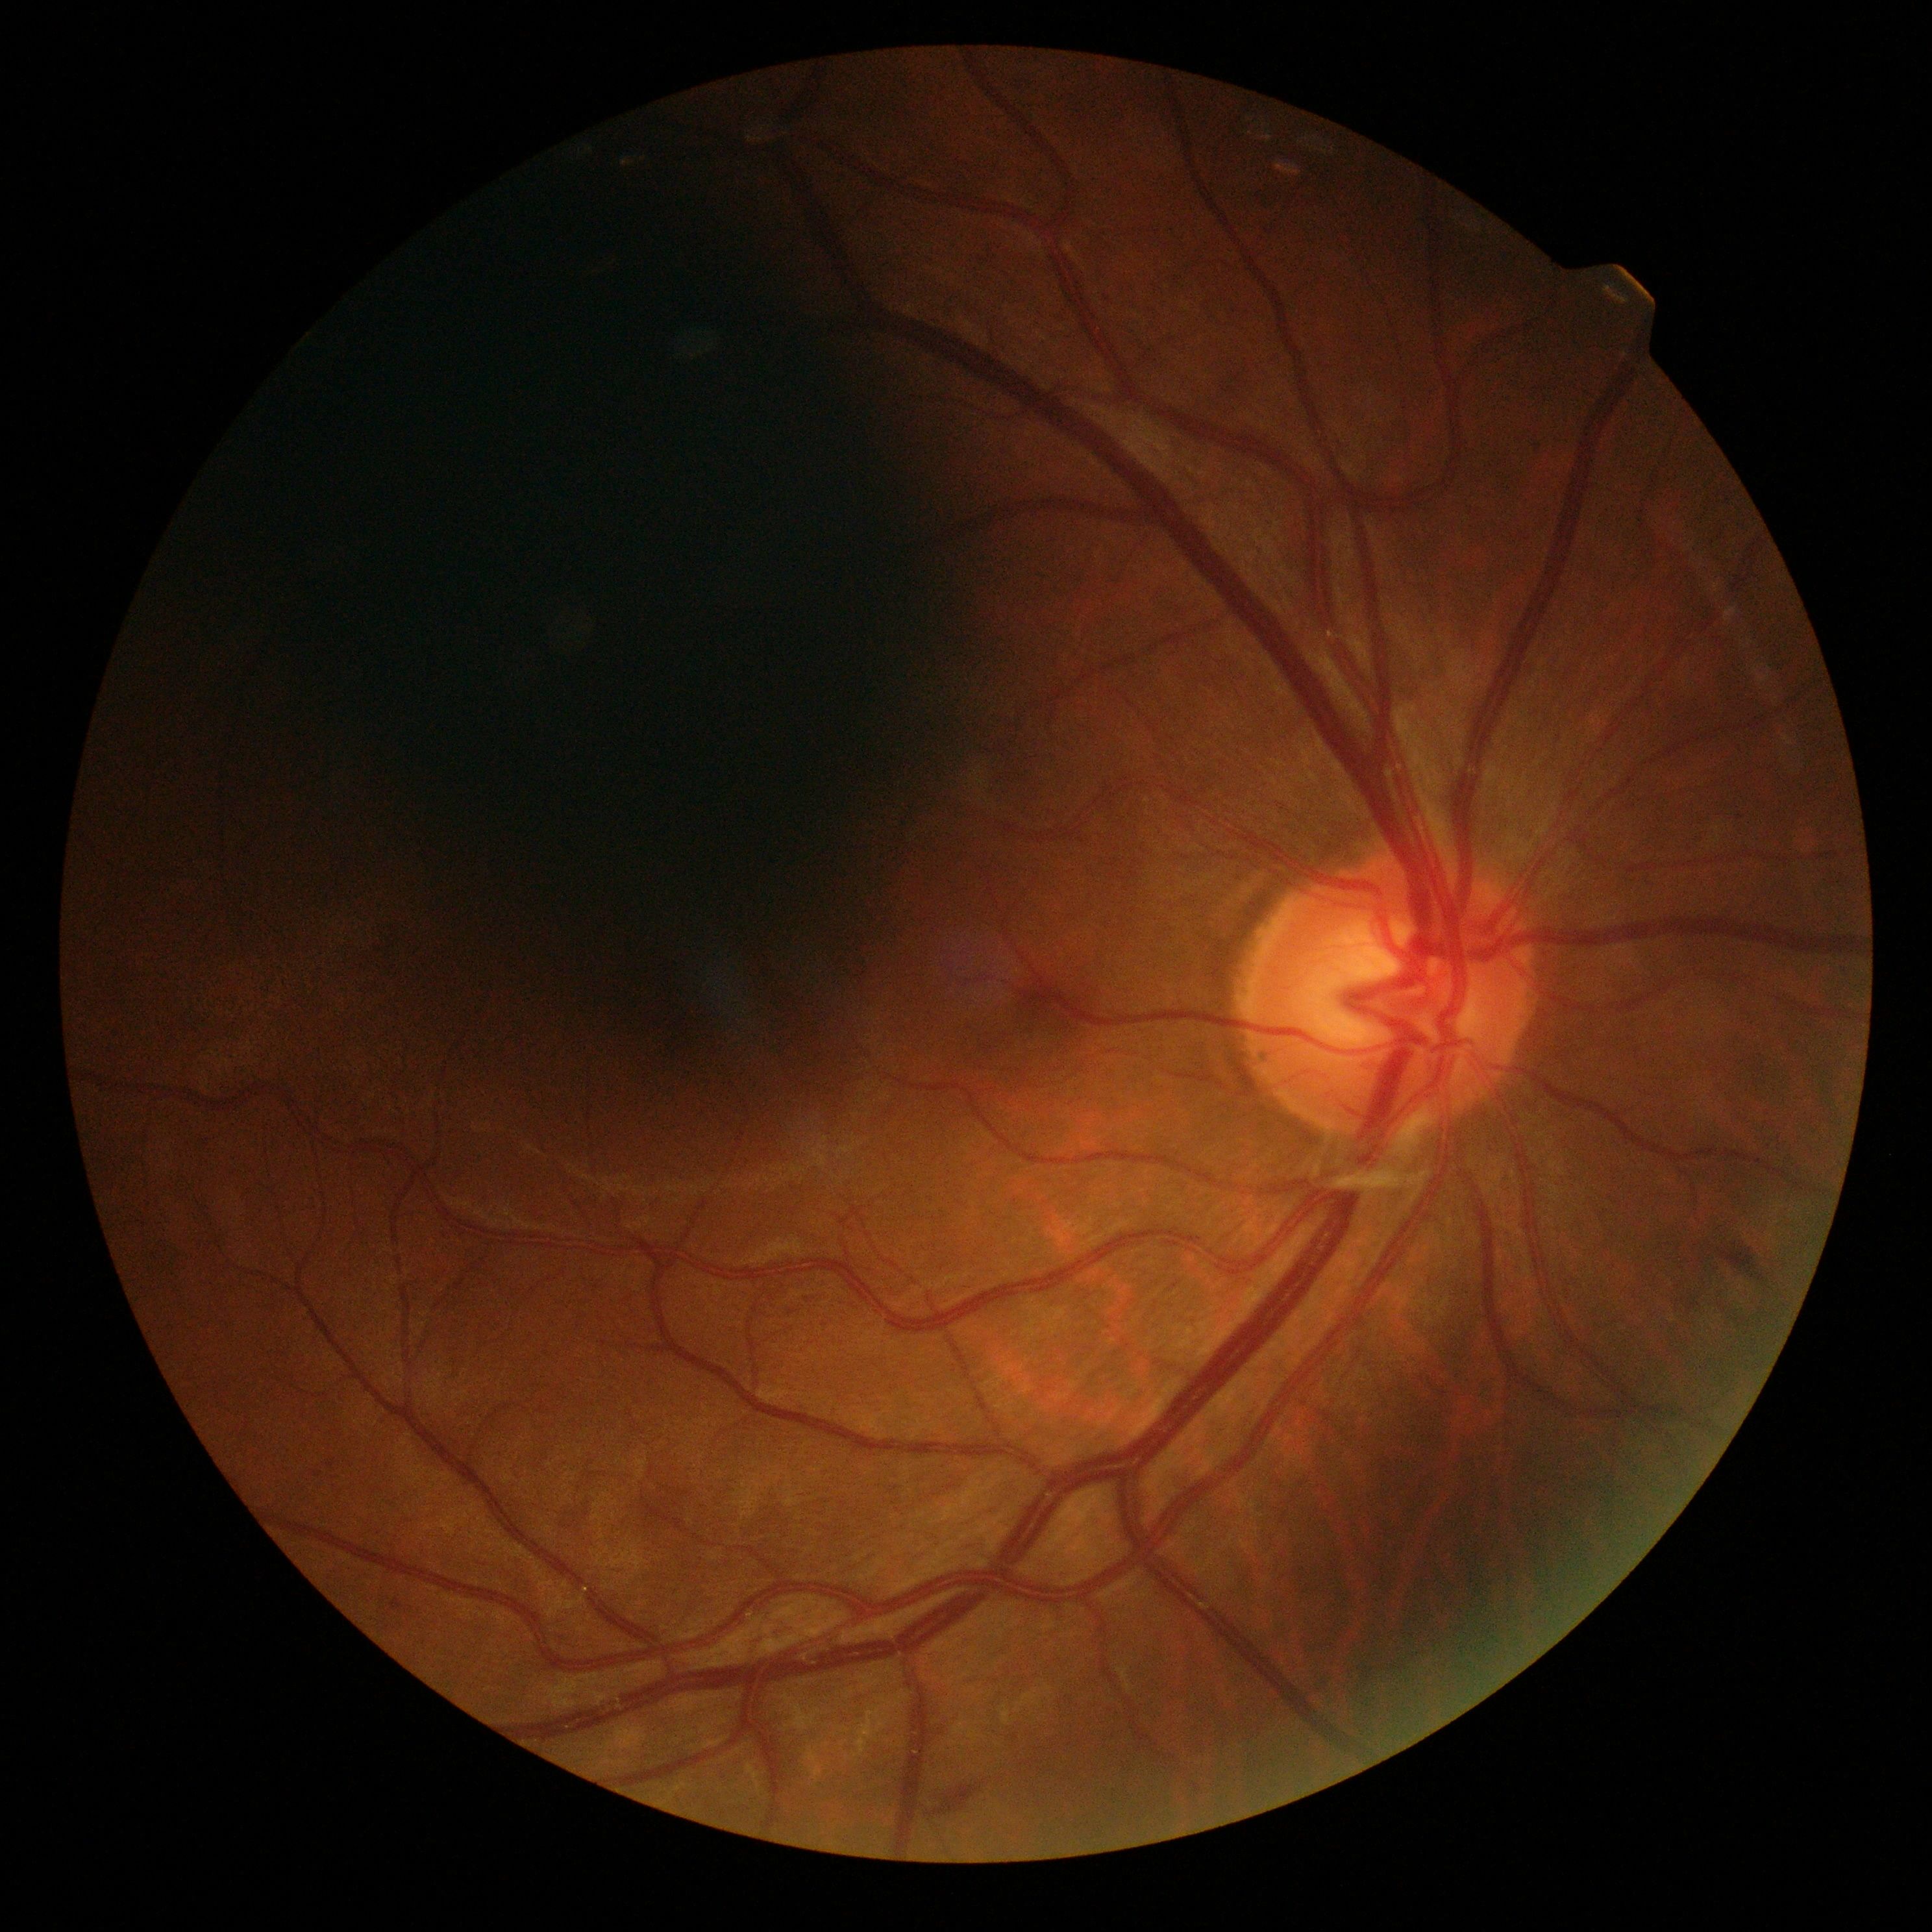   dr_category: non-proliferative diabetic retinopathy
  dr_grade: 2 — more than just microaneurysms but less than severe NPDR